Acquired on the Clarity RetCam 3 · wide-field fundus image from infant ROP screening · 640 x 480 pixels: 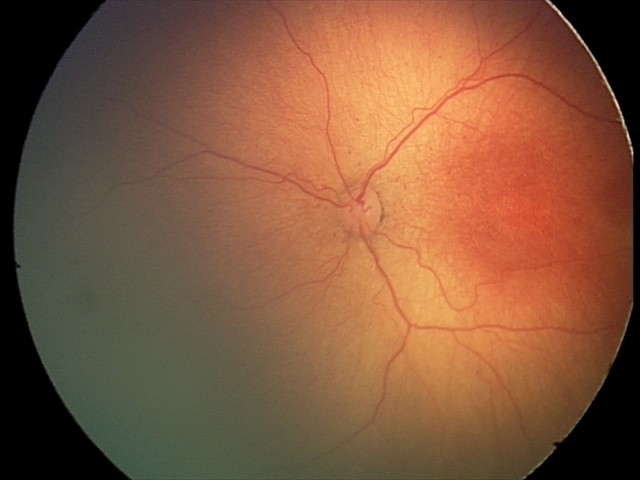 Q: Is plus disease present?
A: no plus disease — posterior pole vessels without abnormal dilation or tortuosity
Q: What is the screening diagnosis?
A: retinopathy of prematurity (ROP) stage 2